CFP, 2048 x 1536 pixels
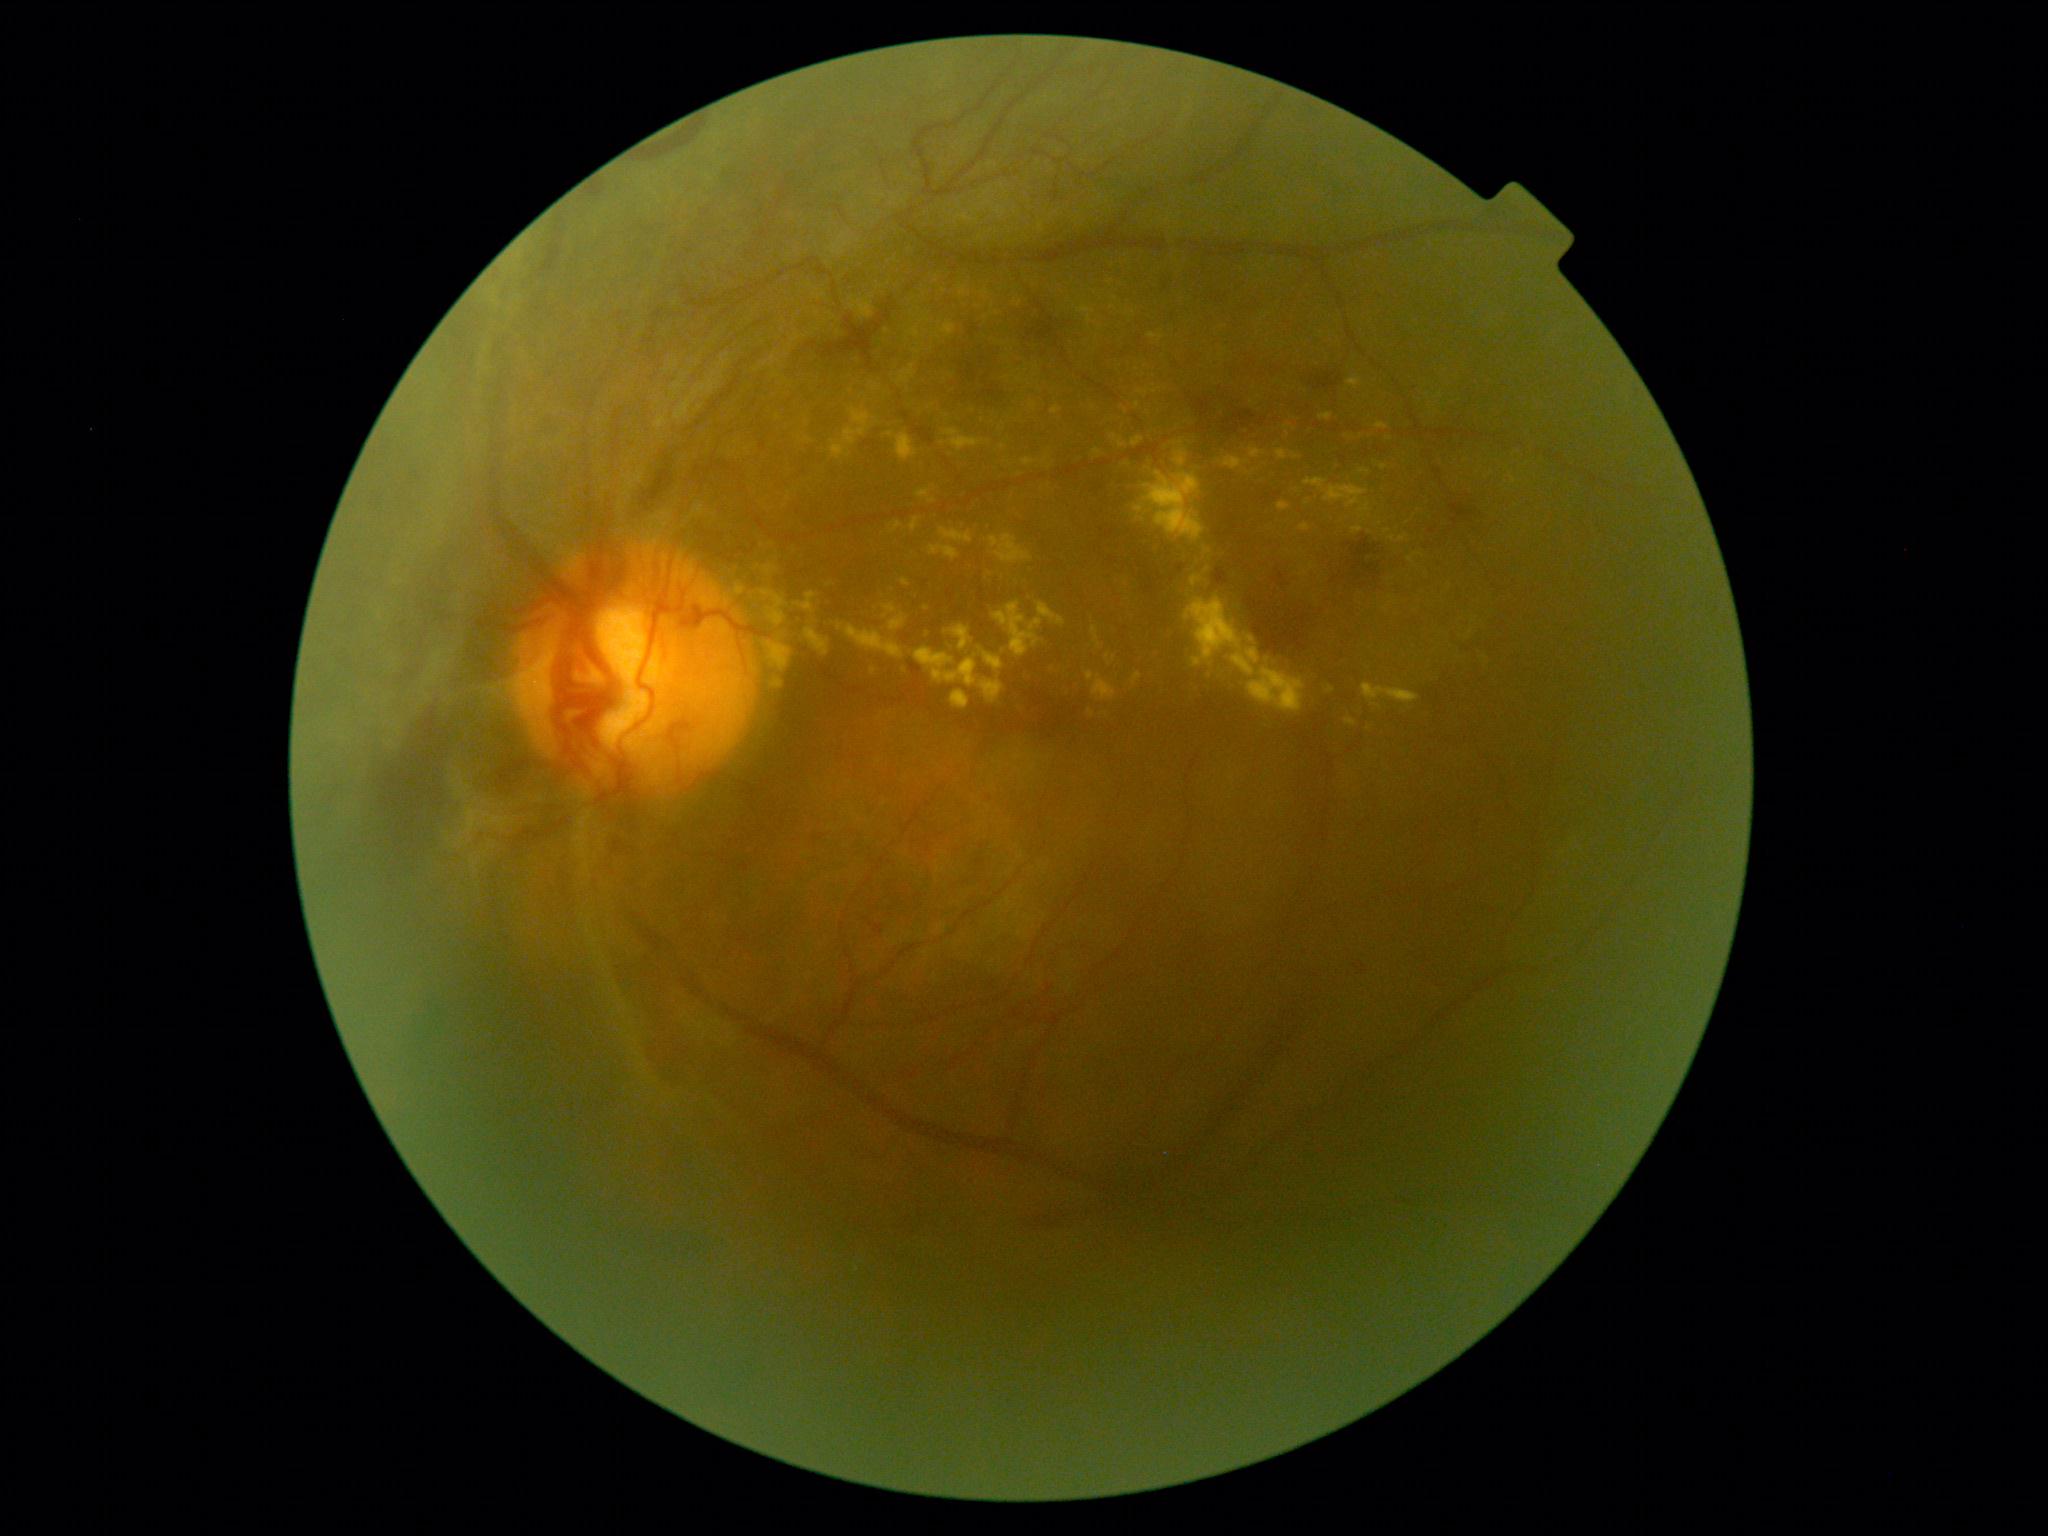
DR grade is PDR (4). Disease class: proliferative diabetic retinopathy.